1932x1916 · color fundus image · 45-degree field of view:
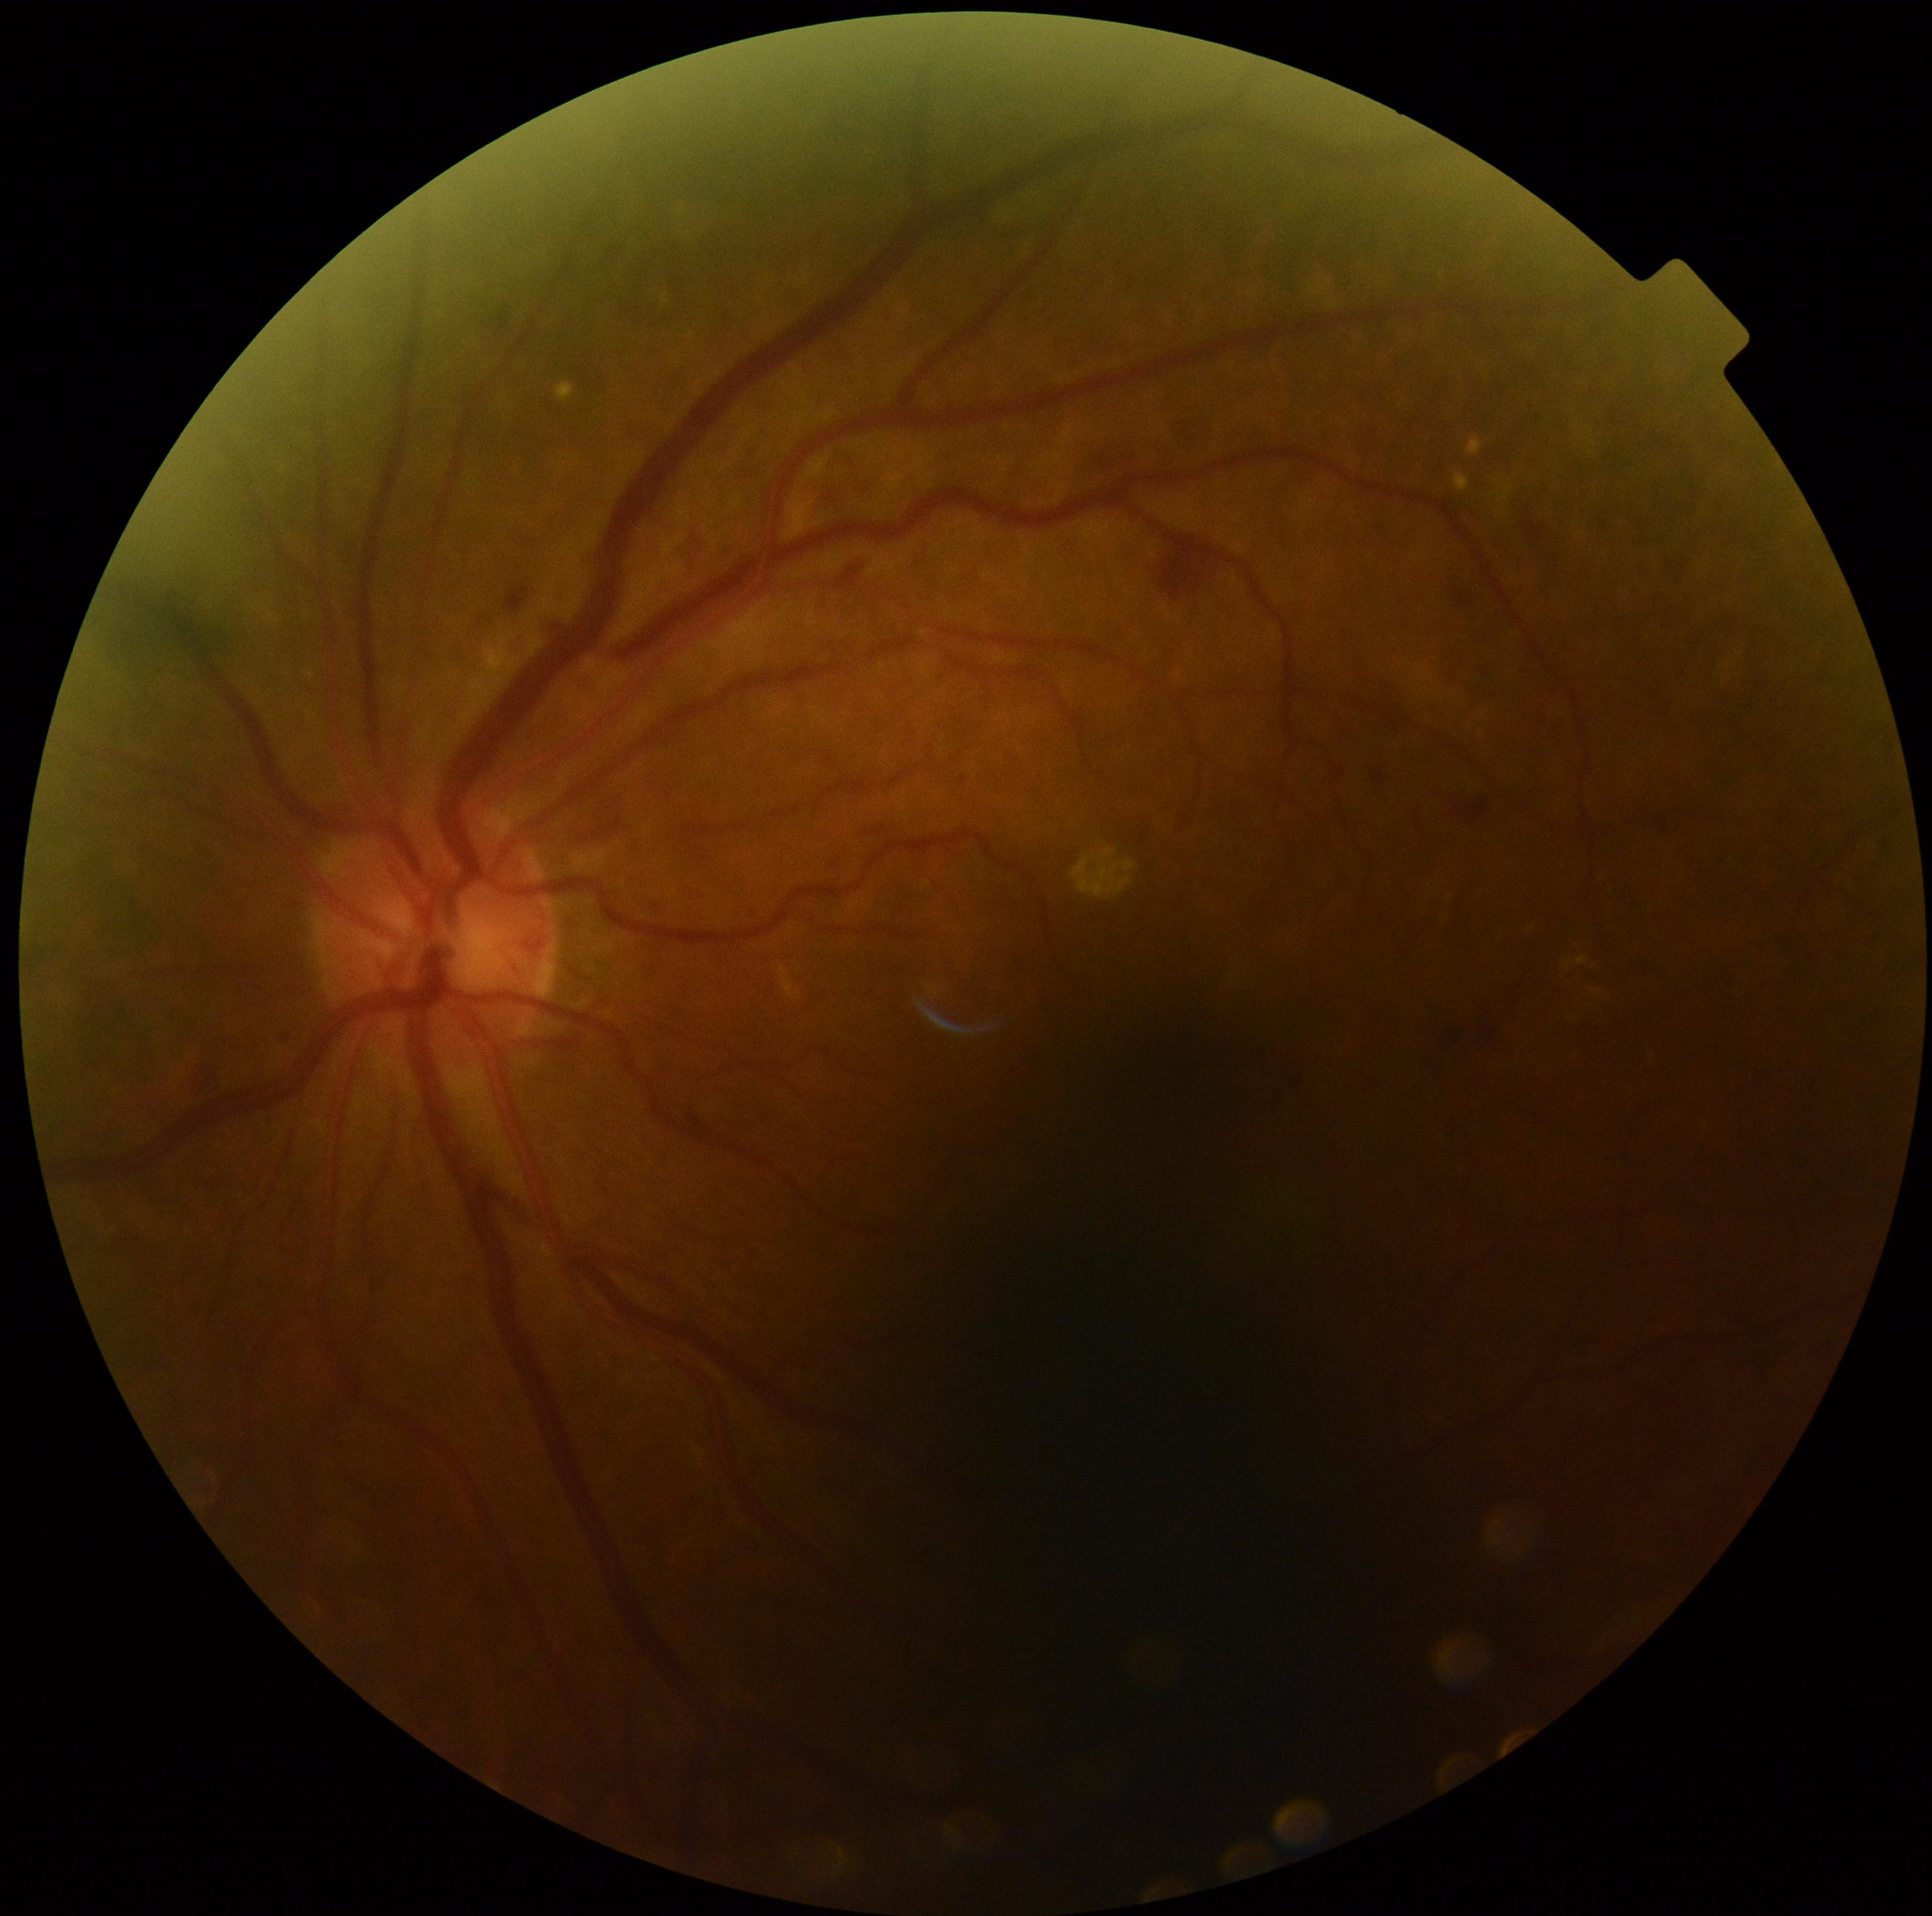 Diabetic retinopathy grade is moderate NPDR (2).